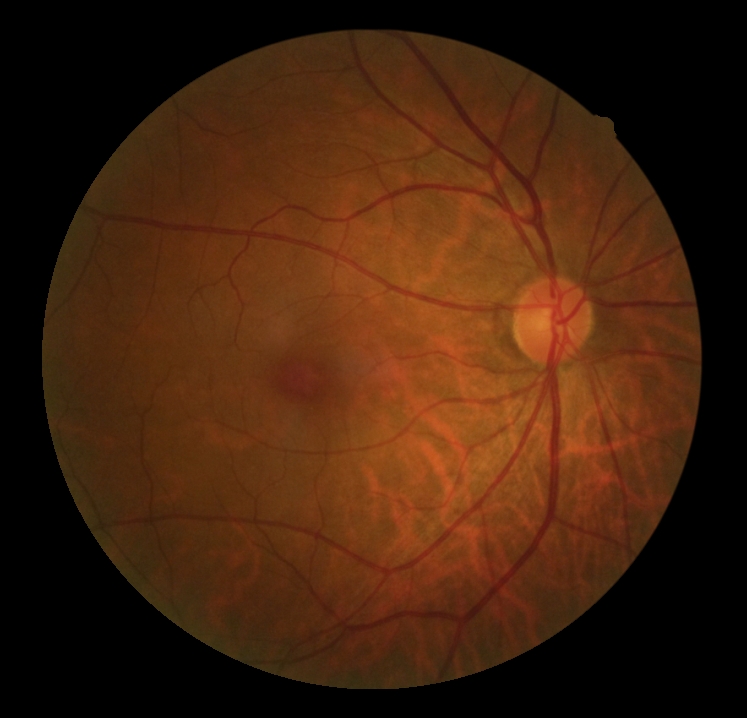

Findings:
* retinopathy — 0/4
* DR impression — no signs of DR